848 by 848 pixels; nonmydriatic fundus photograph; acquired with a NIDEK AFC-230; color fundus photograph:
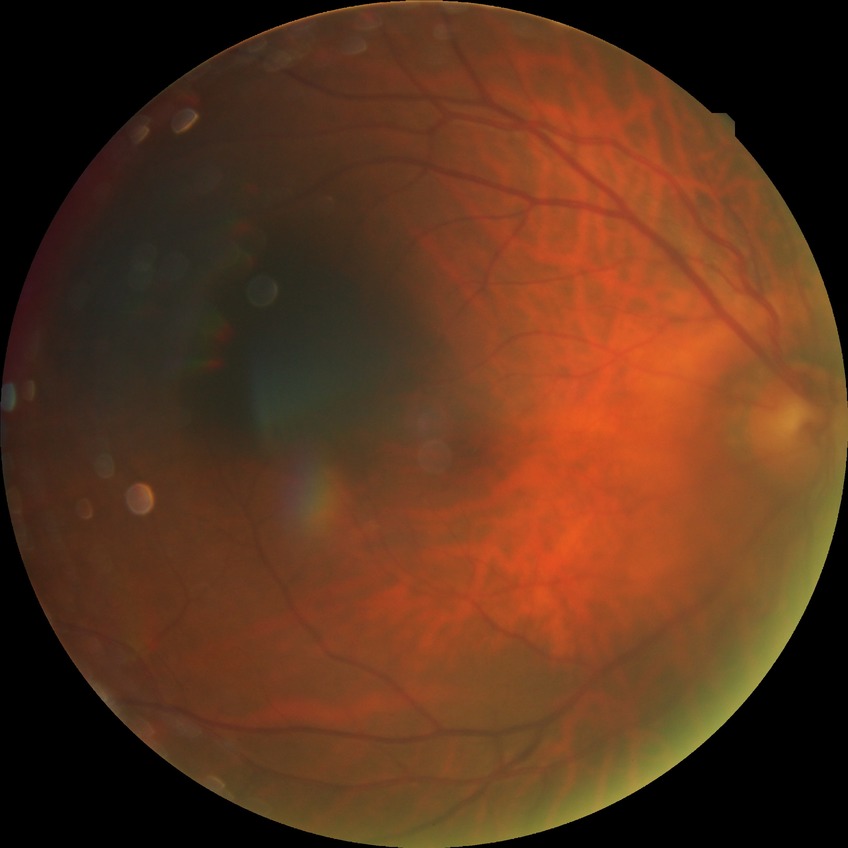
DR stage: NDR. No DR findings.